2212 by 1659 pixels, 45° FOV:
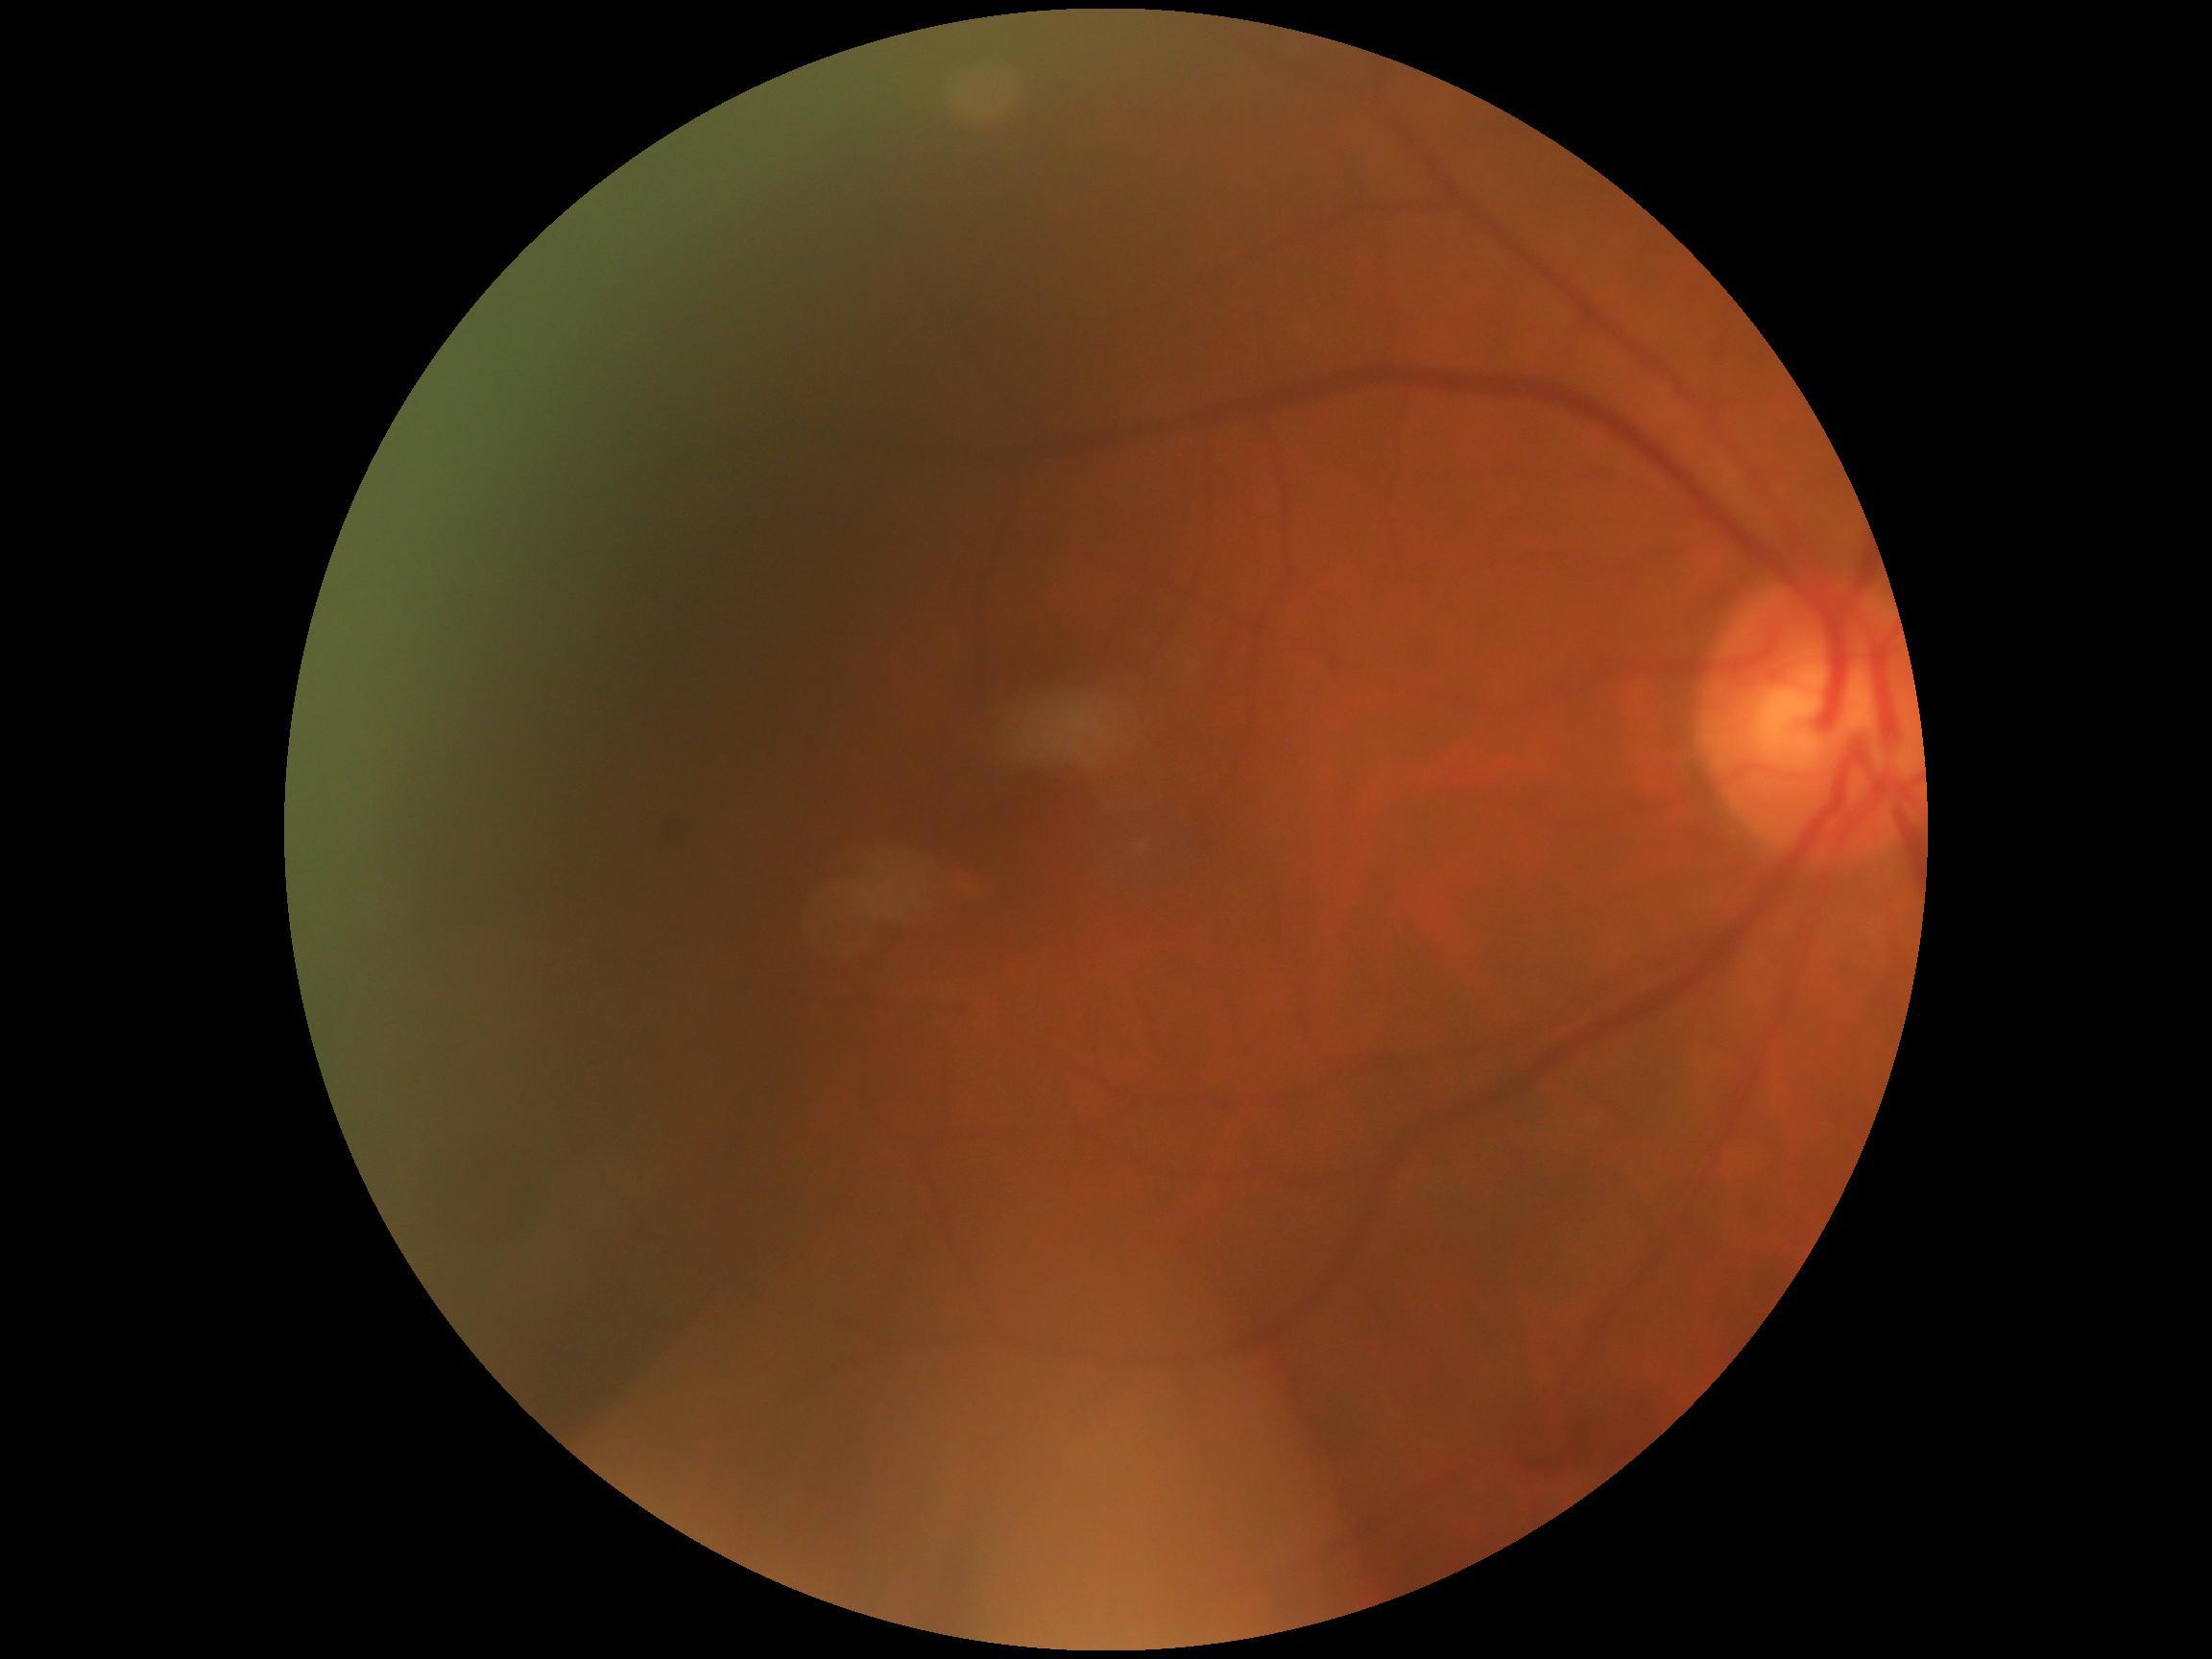 DR is no apparent diabetic retinopathy (grade 0). No DR findings.